FOV: 45 degrees — 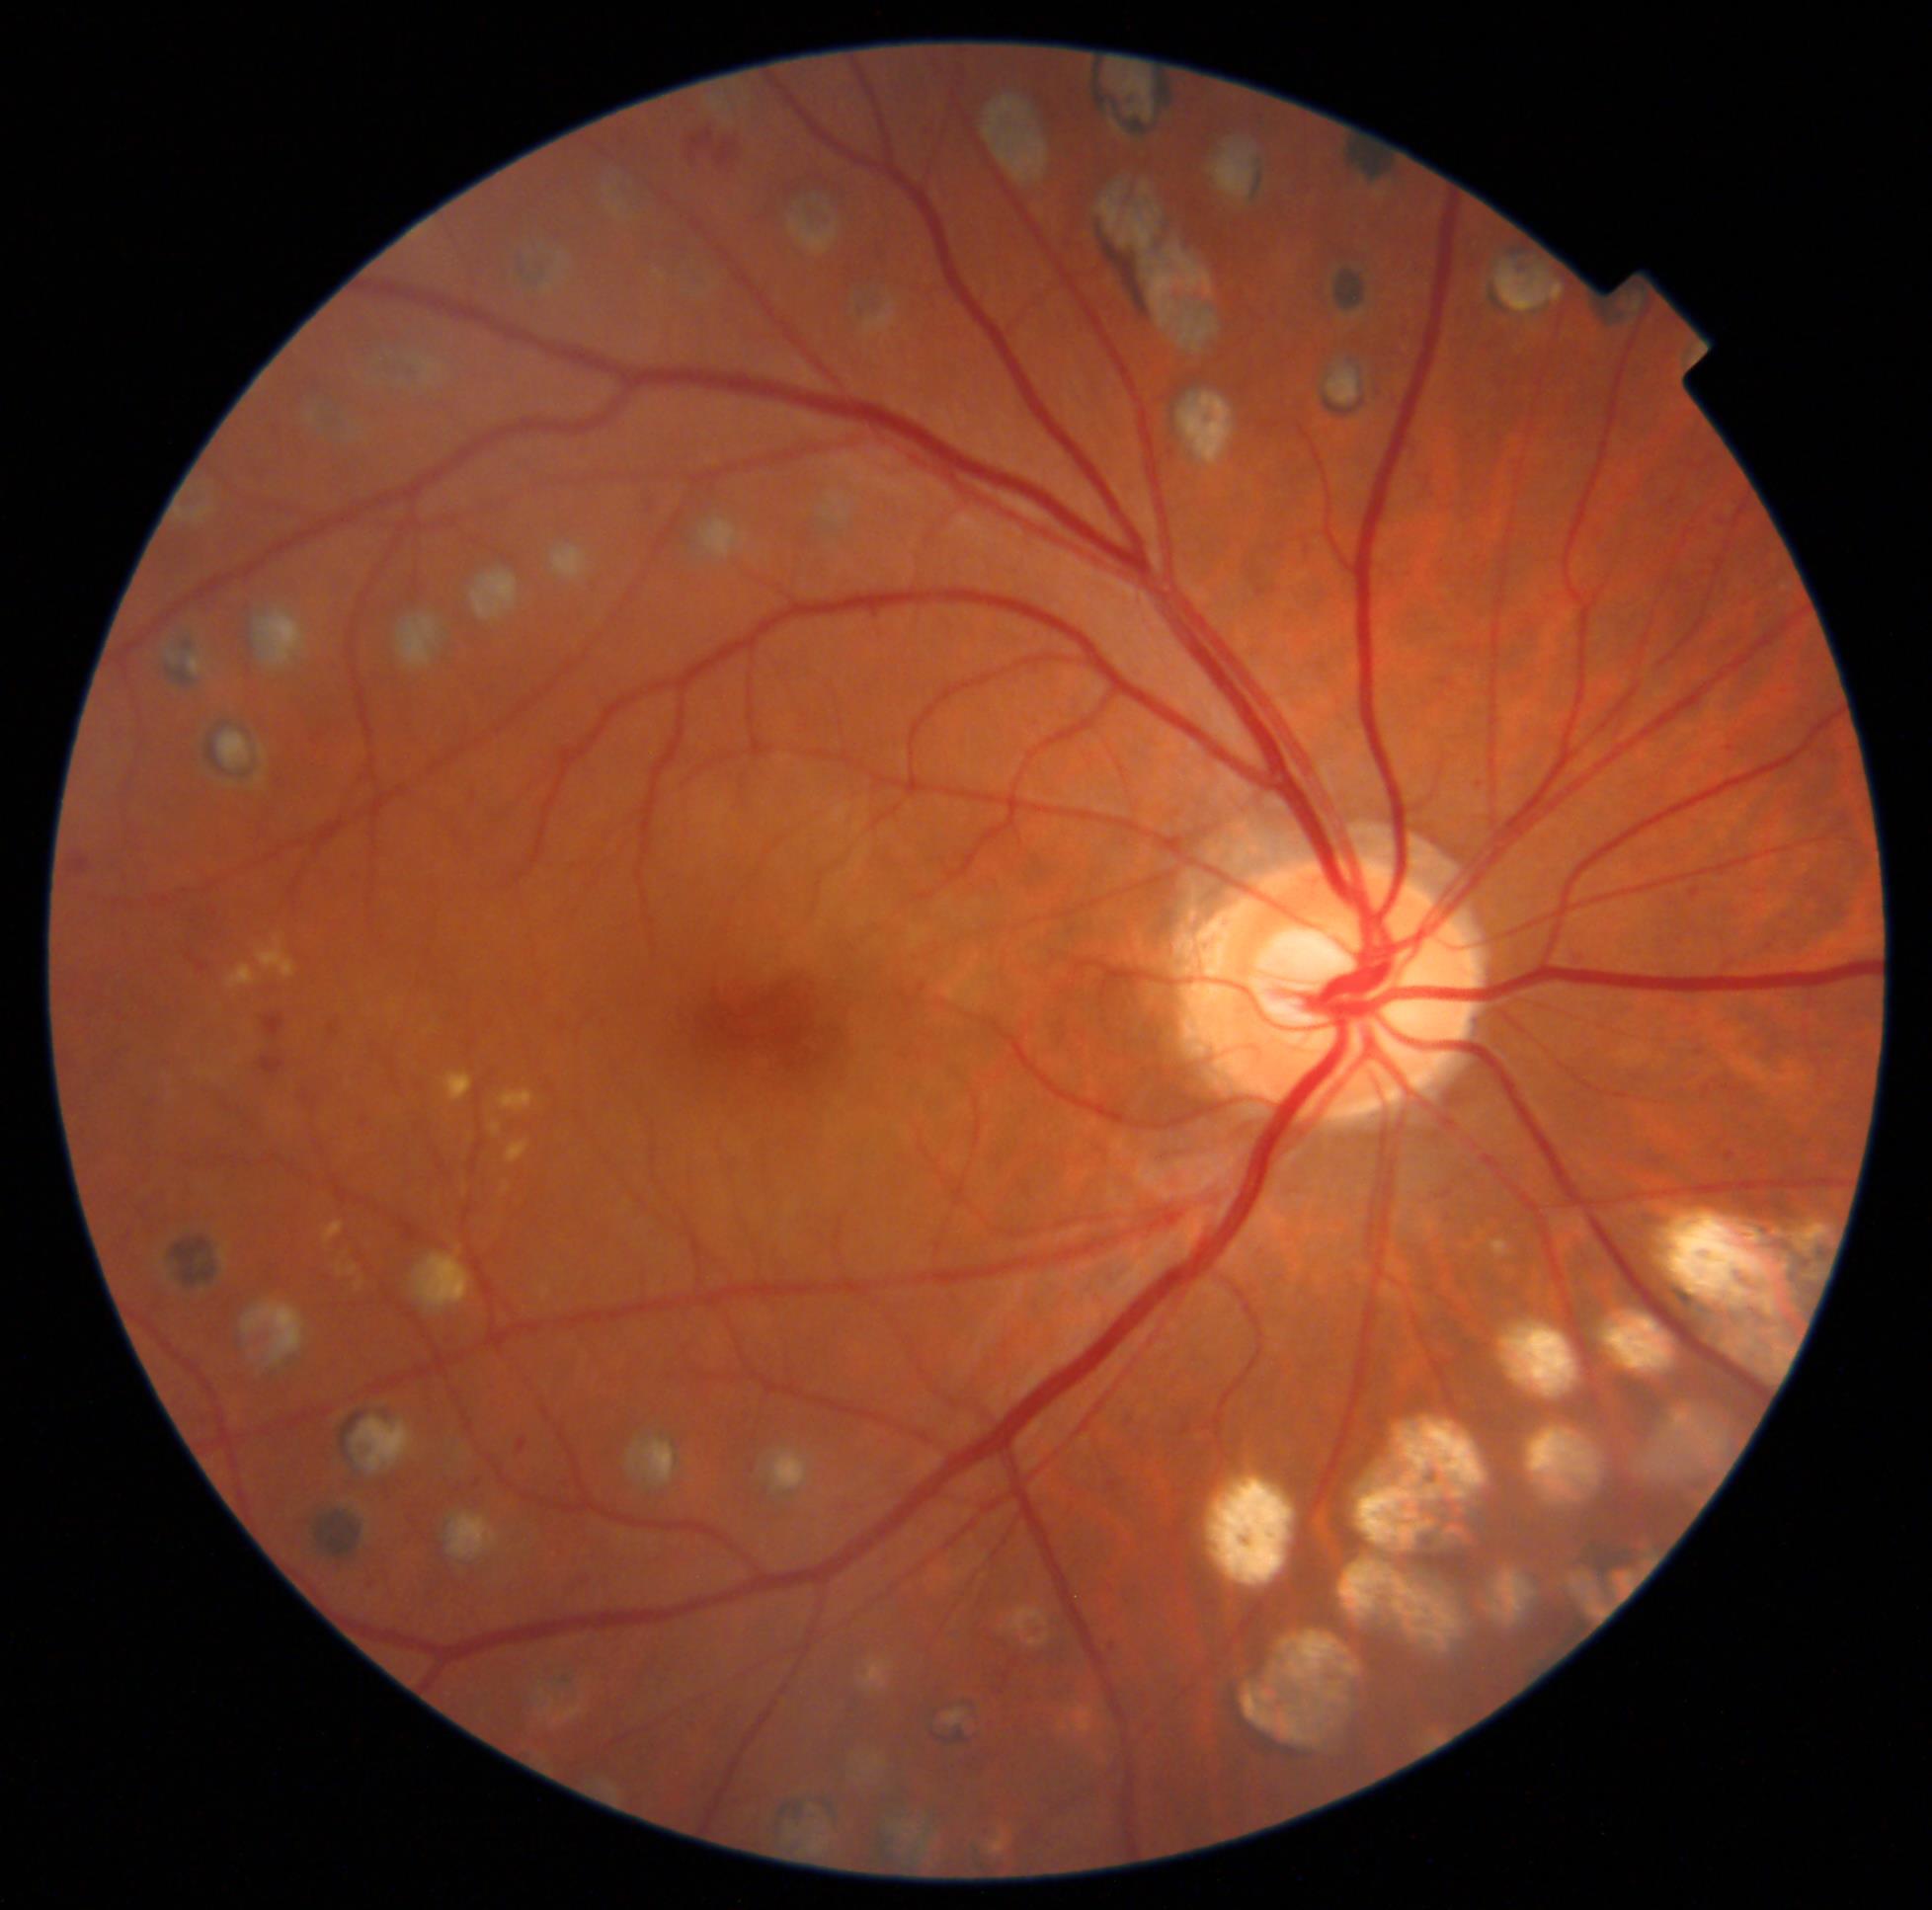
DR severity: moderate NPDR (grade 2). DR class: non-proliferative diabetic retinopathy.